200° field of view; 1924 x 1556 pixels:
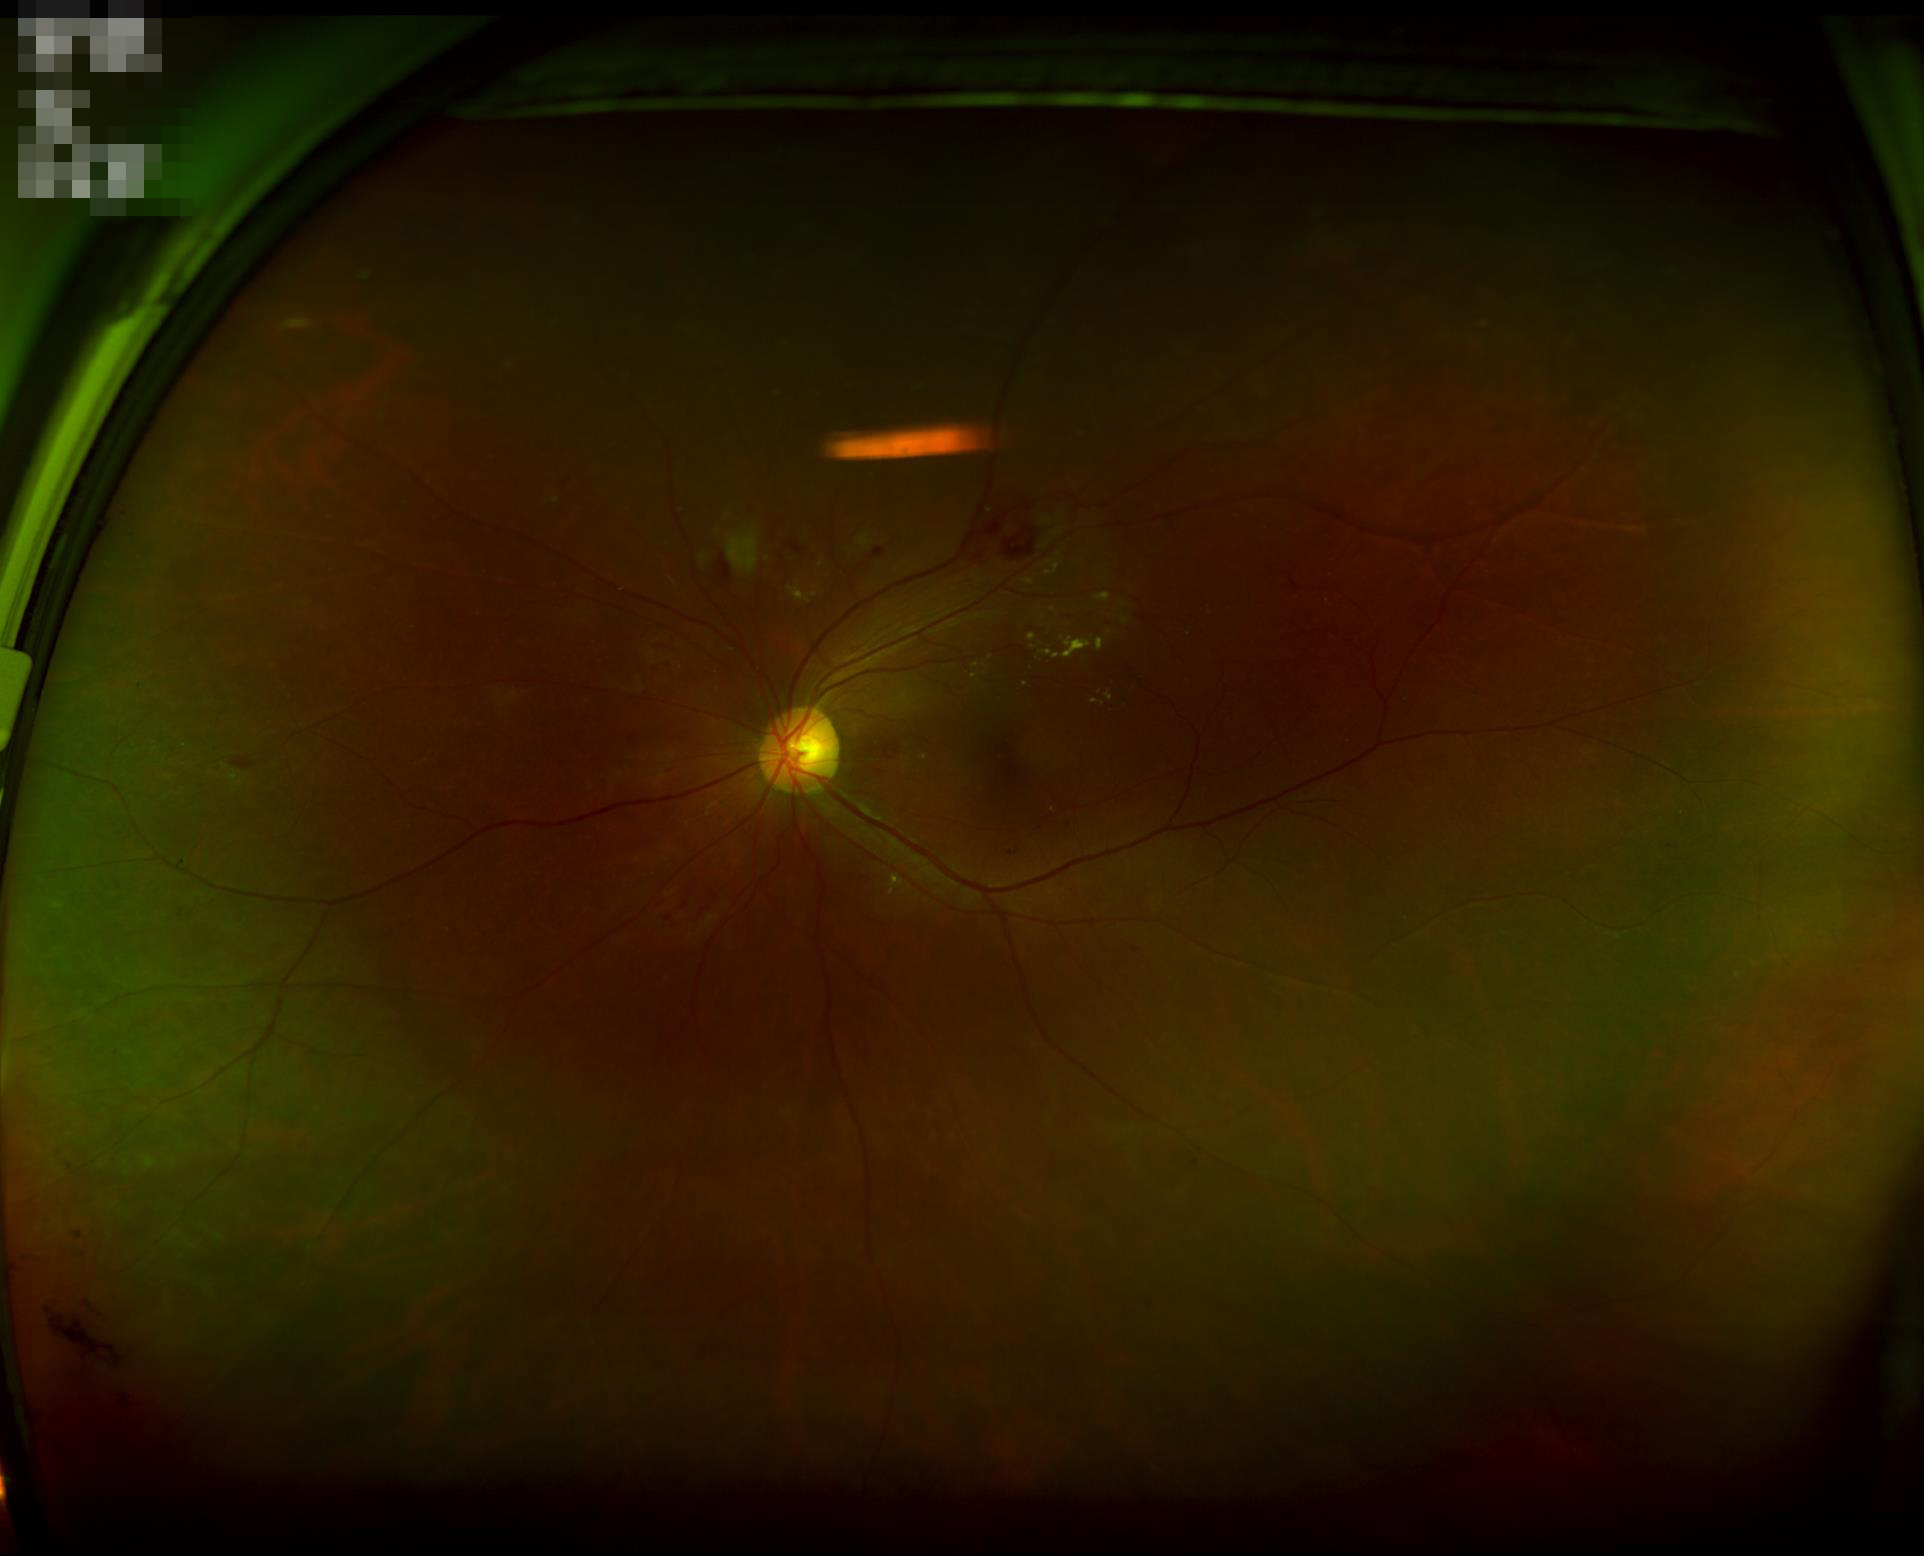
Focus: in focus | Illumination/color: poor | Contrast: adequate | Overall quality: inadequate.